Image size 2352x1568:
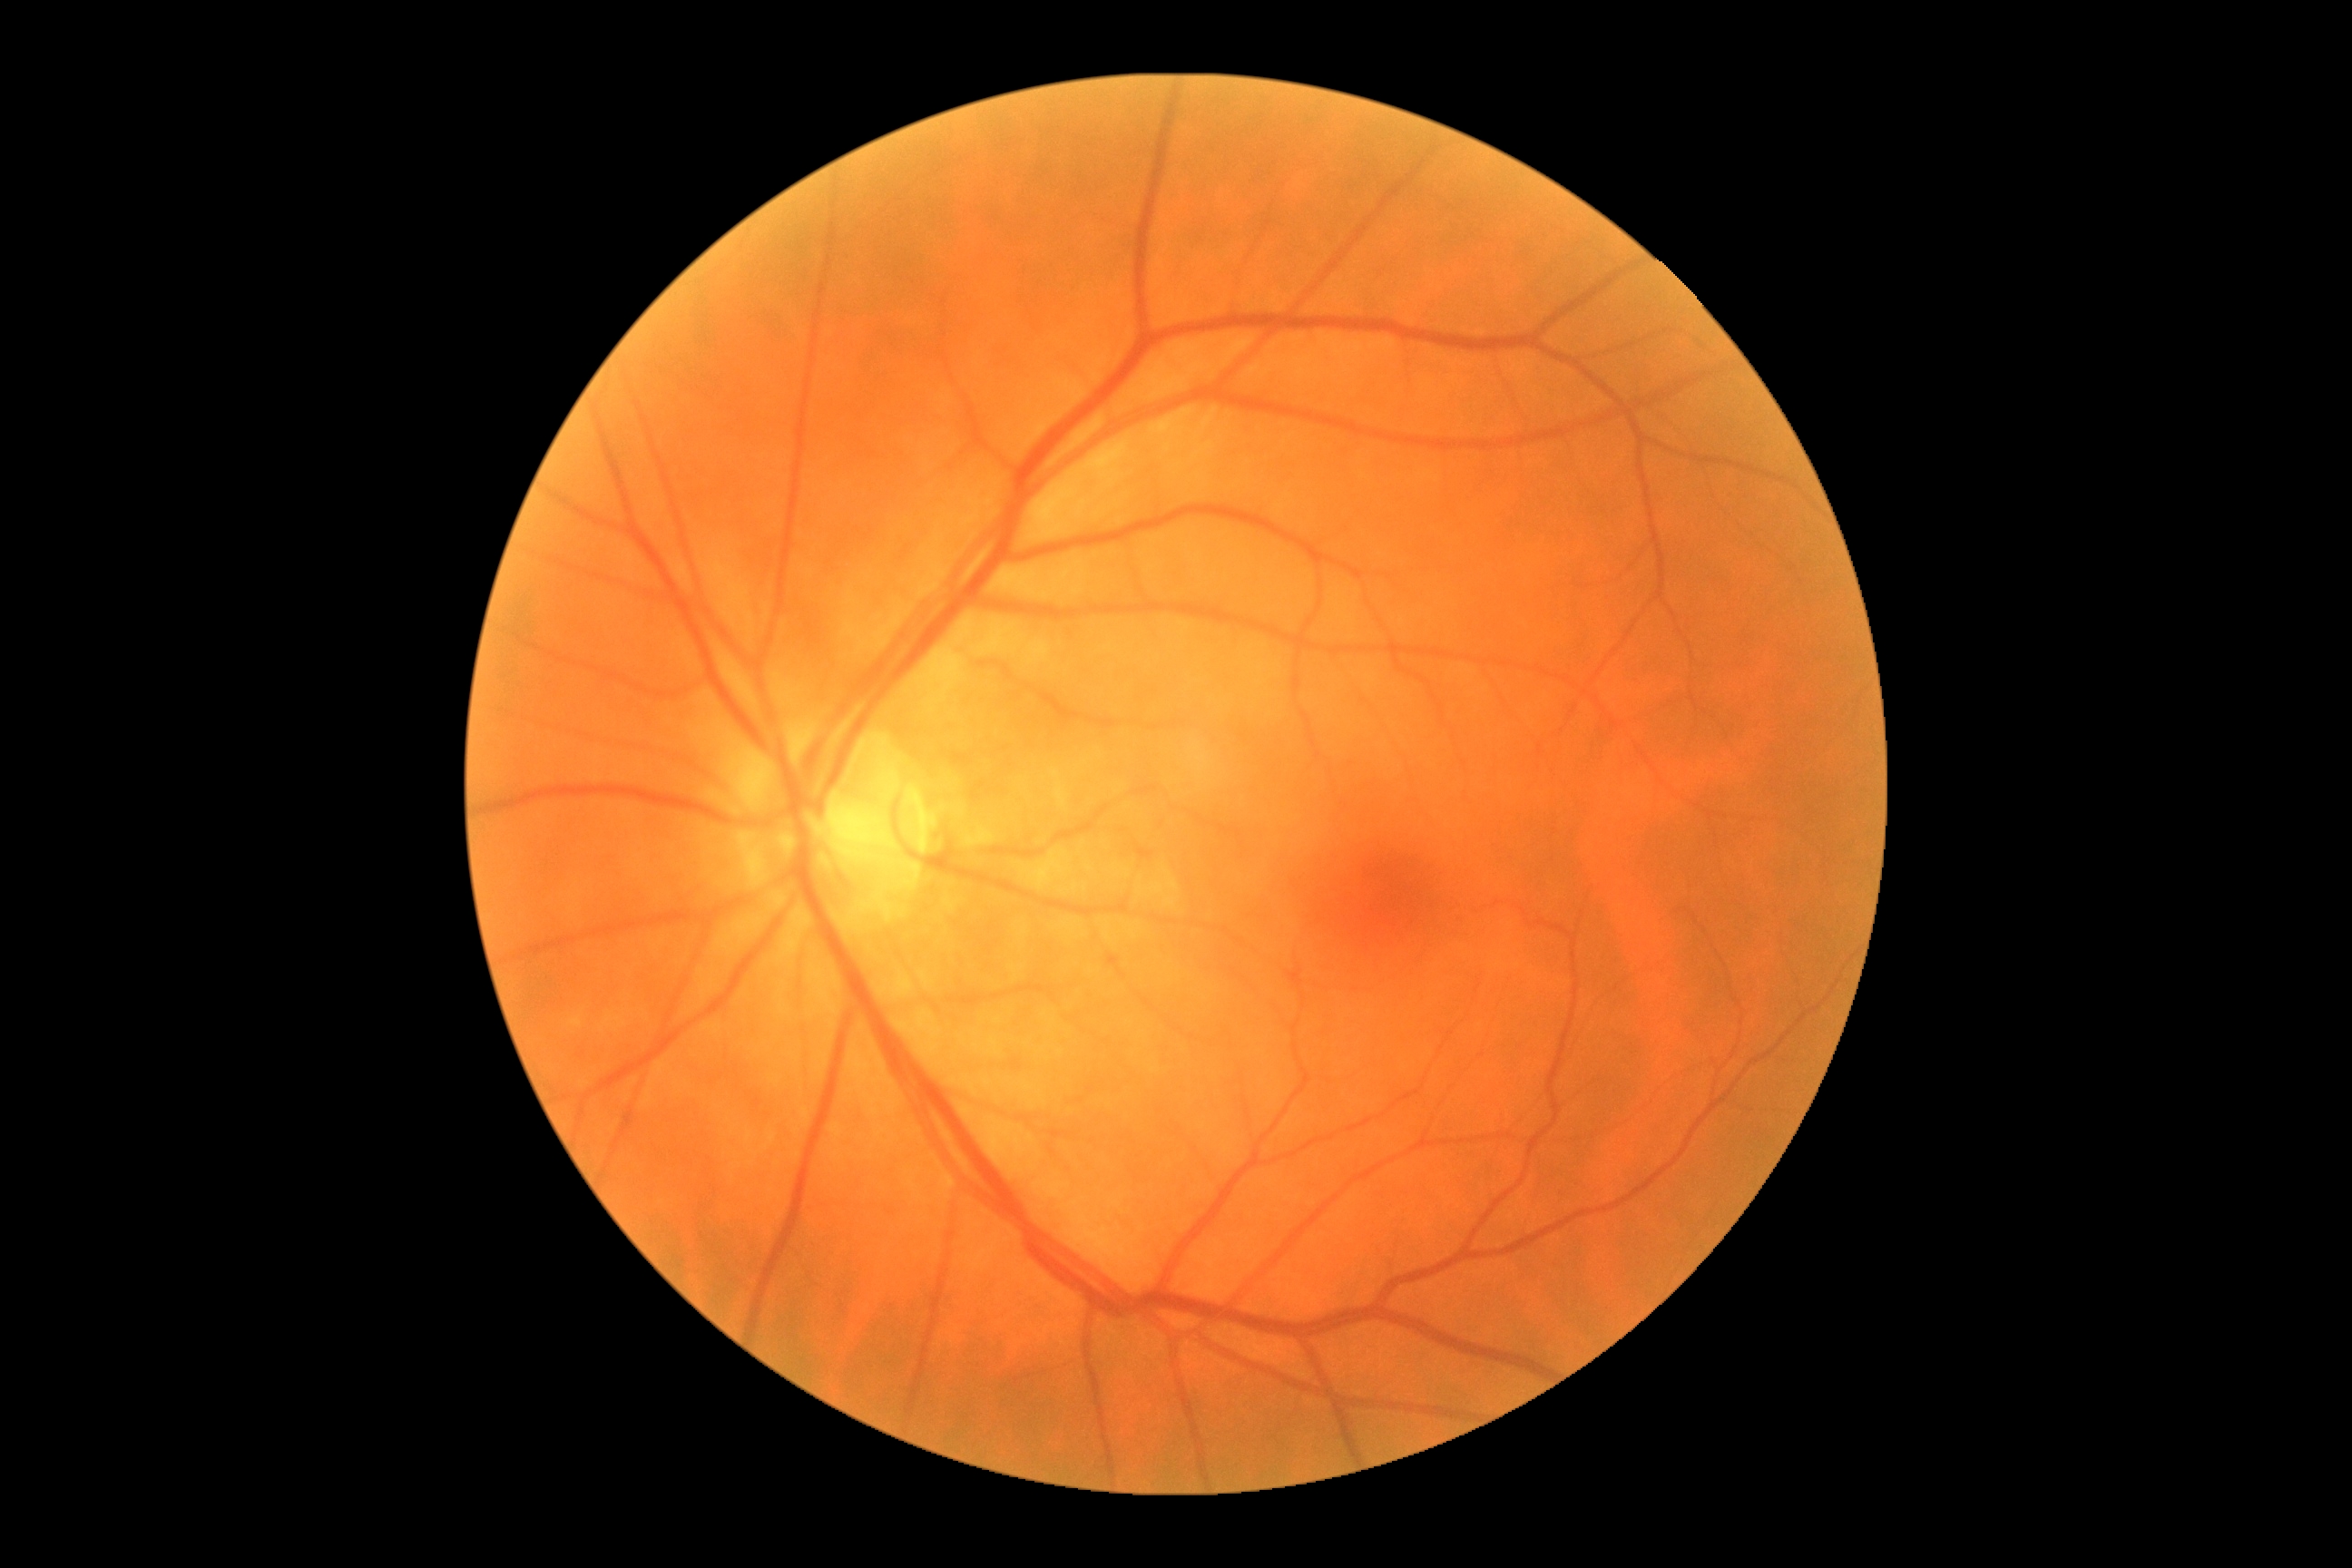 DR: grade 0. No DR findings.